Retinal fundus photograph — 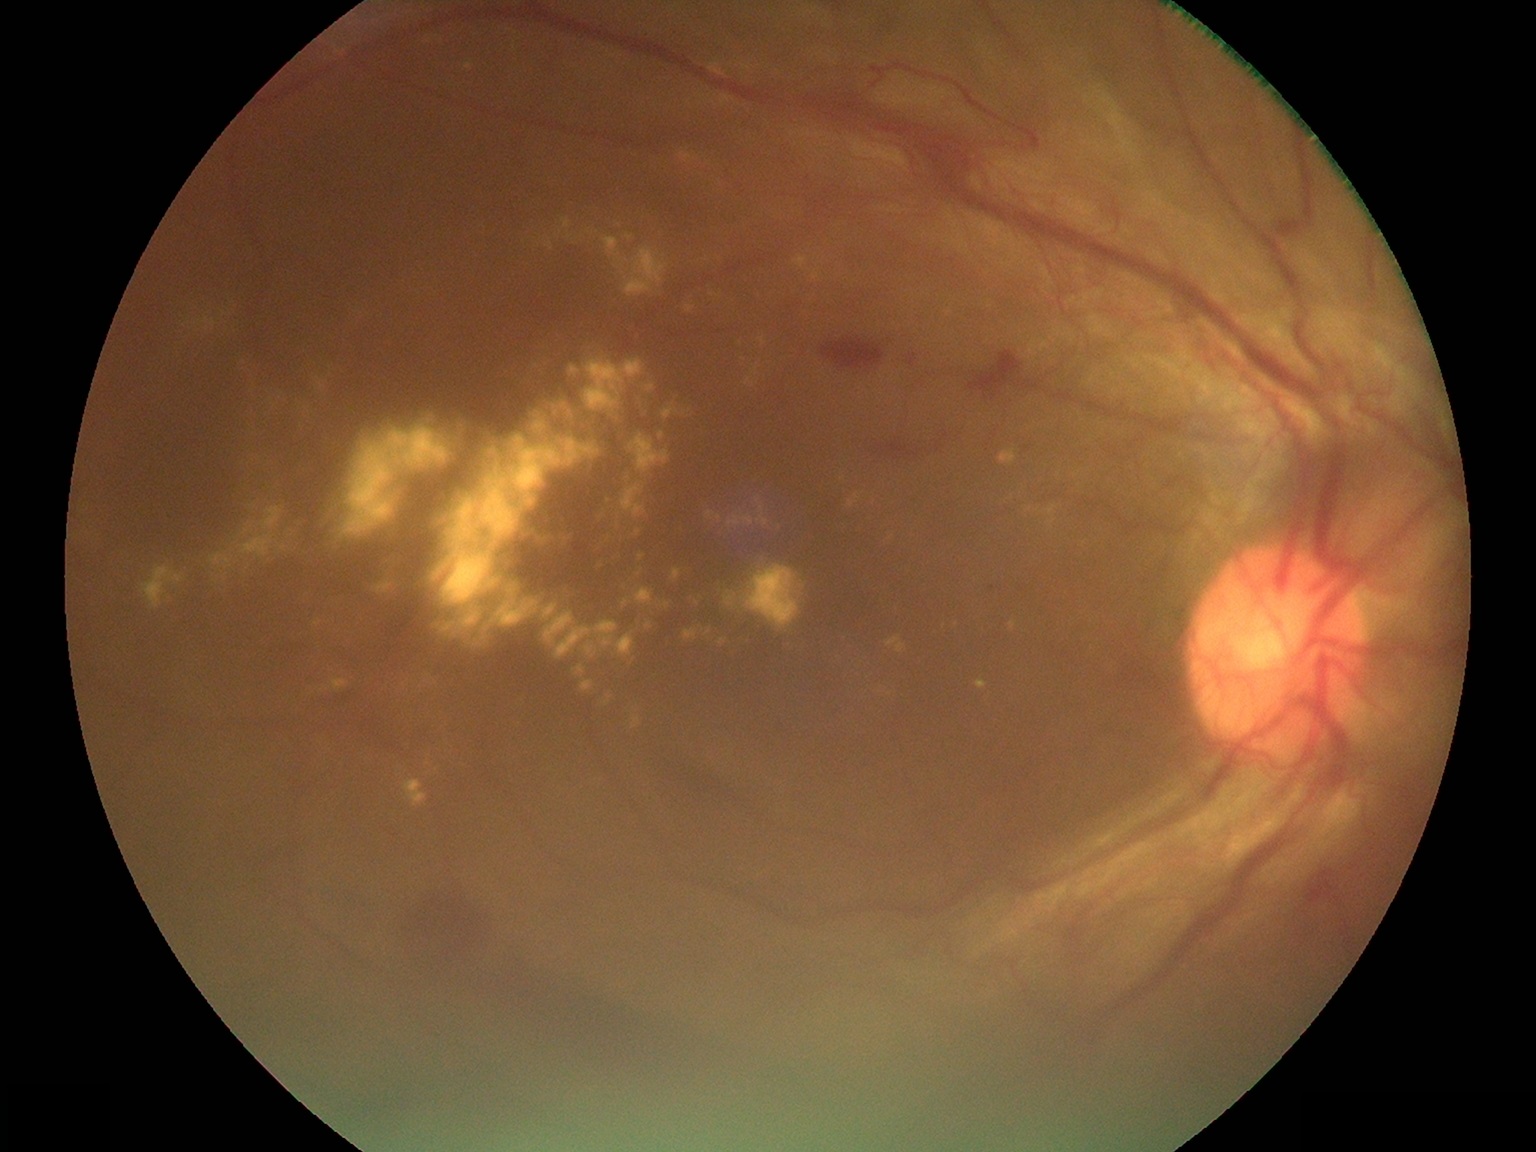

{"partial":true,"dr_grade":4,"dr_grade_name":"PDR","lesions":{"ex":[[581,681,595,695],[533,410,545,419],[636,567,644,577],[249,504,259,509],[372,574,399,596],[758,336,767,347],[270,398,279,412],[848,493,864,509],[1010,621,1017,630],[885,636,907,654],[584,359,646,413],[569,363,581,377]],"ex_small_approx":[[1012,499],[588,231],[537,366],[736,595],[944,627],[307,408]]}}